Modified Davis classification: 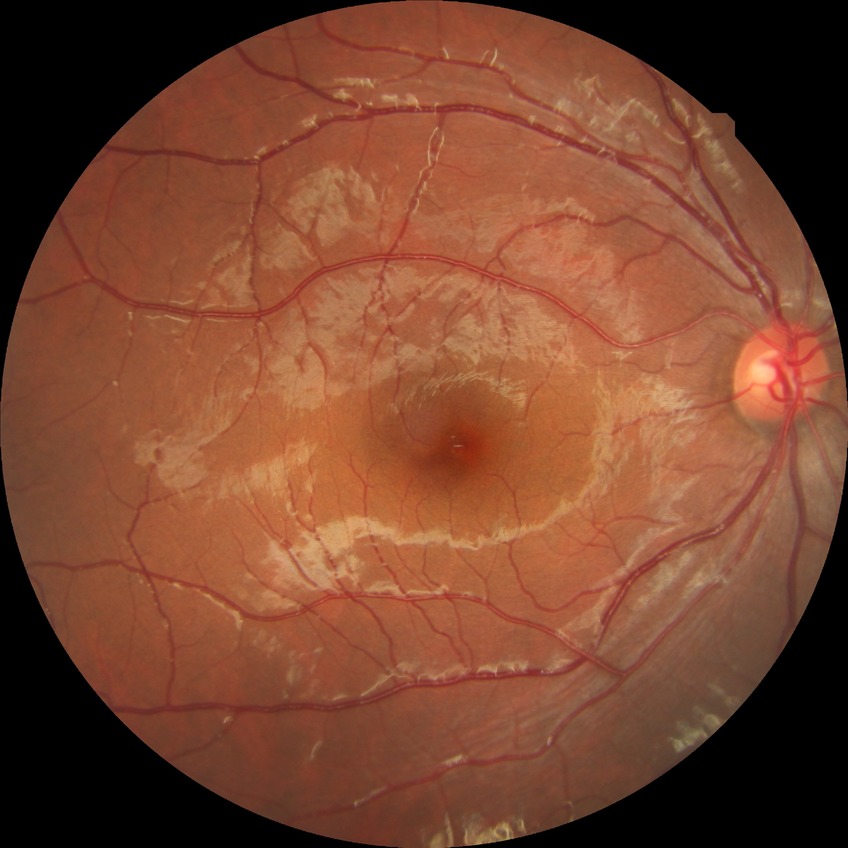

Modified Davis classification is no diabetic retinopathy.